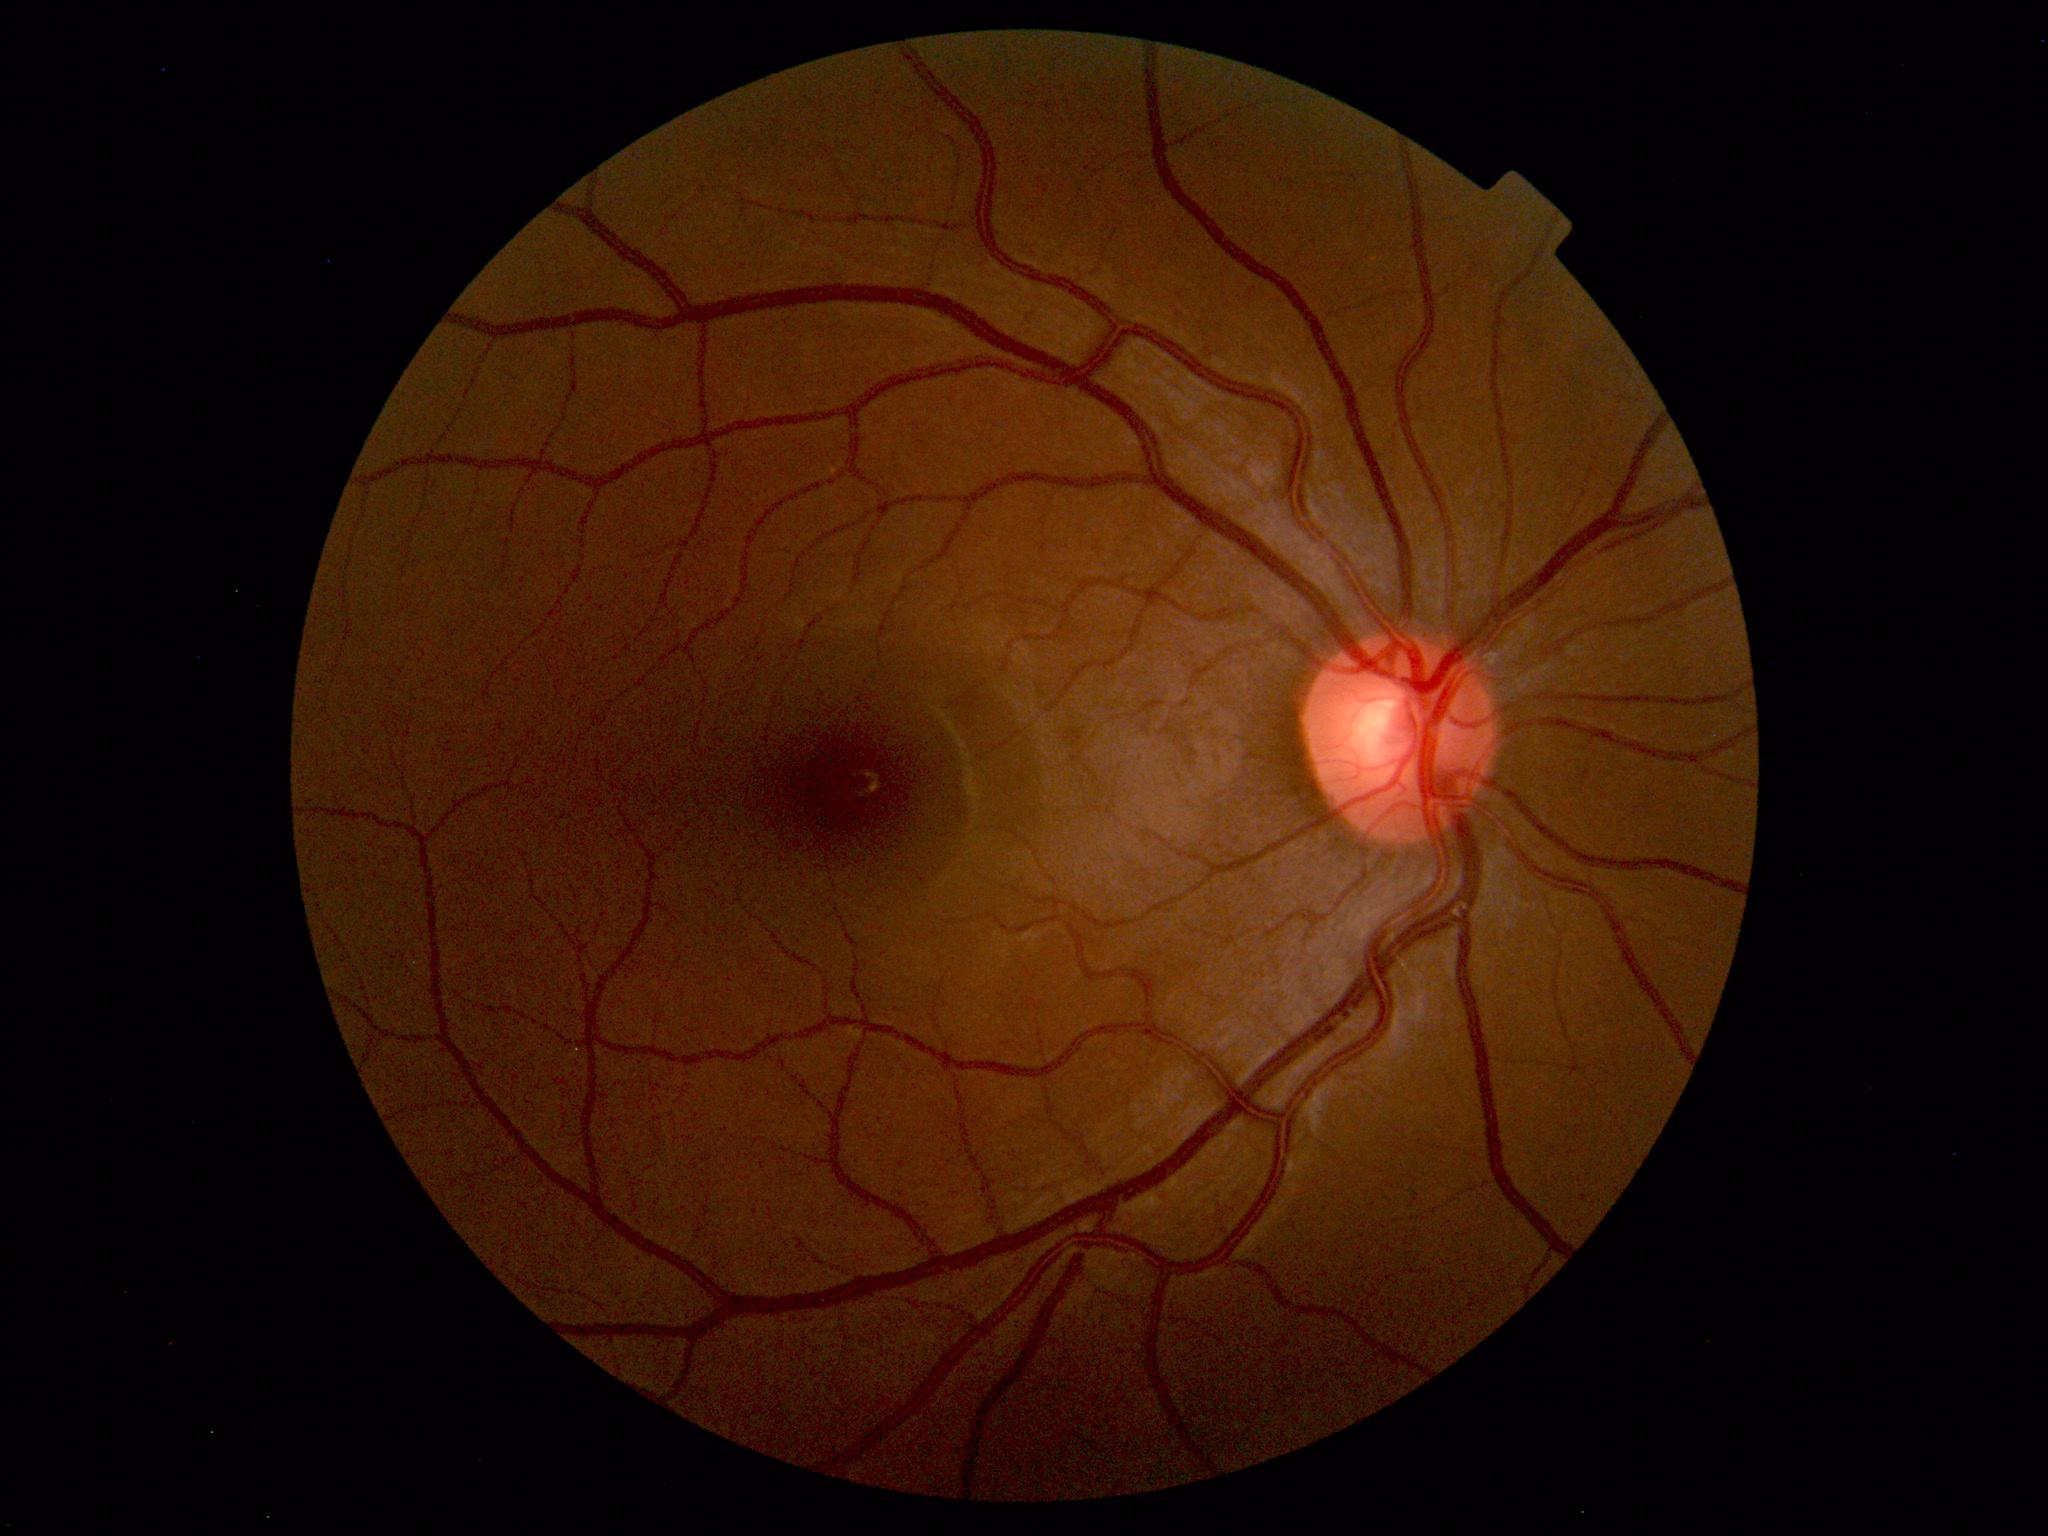 Diagnosis: normal.